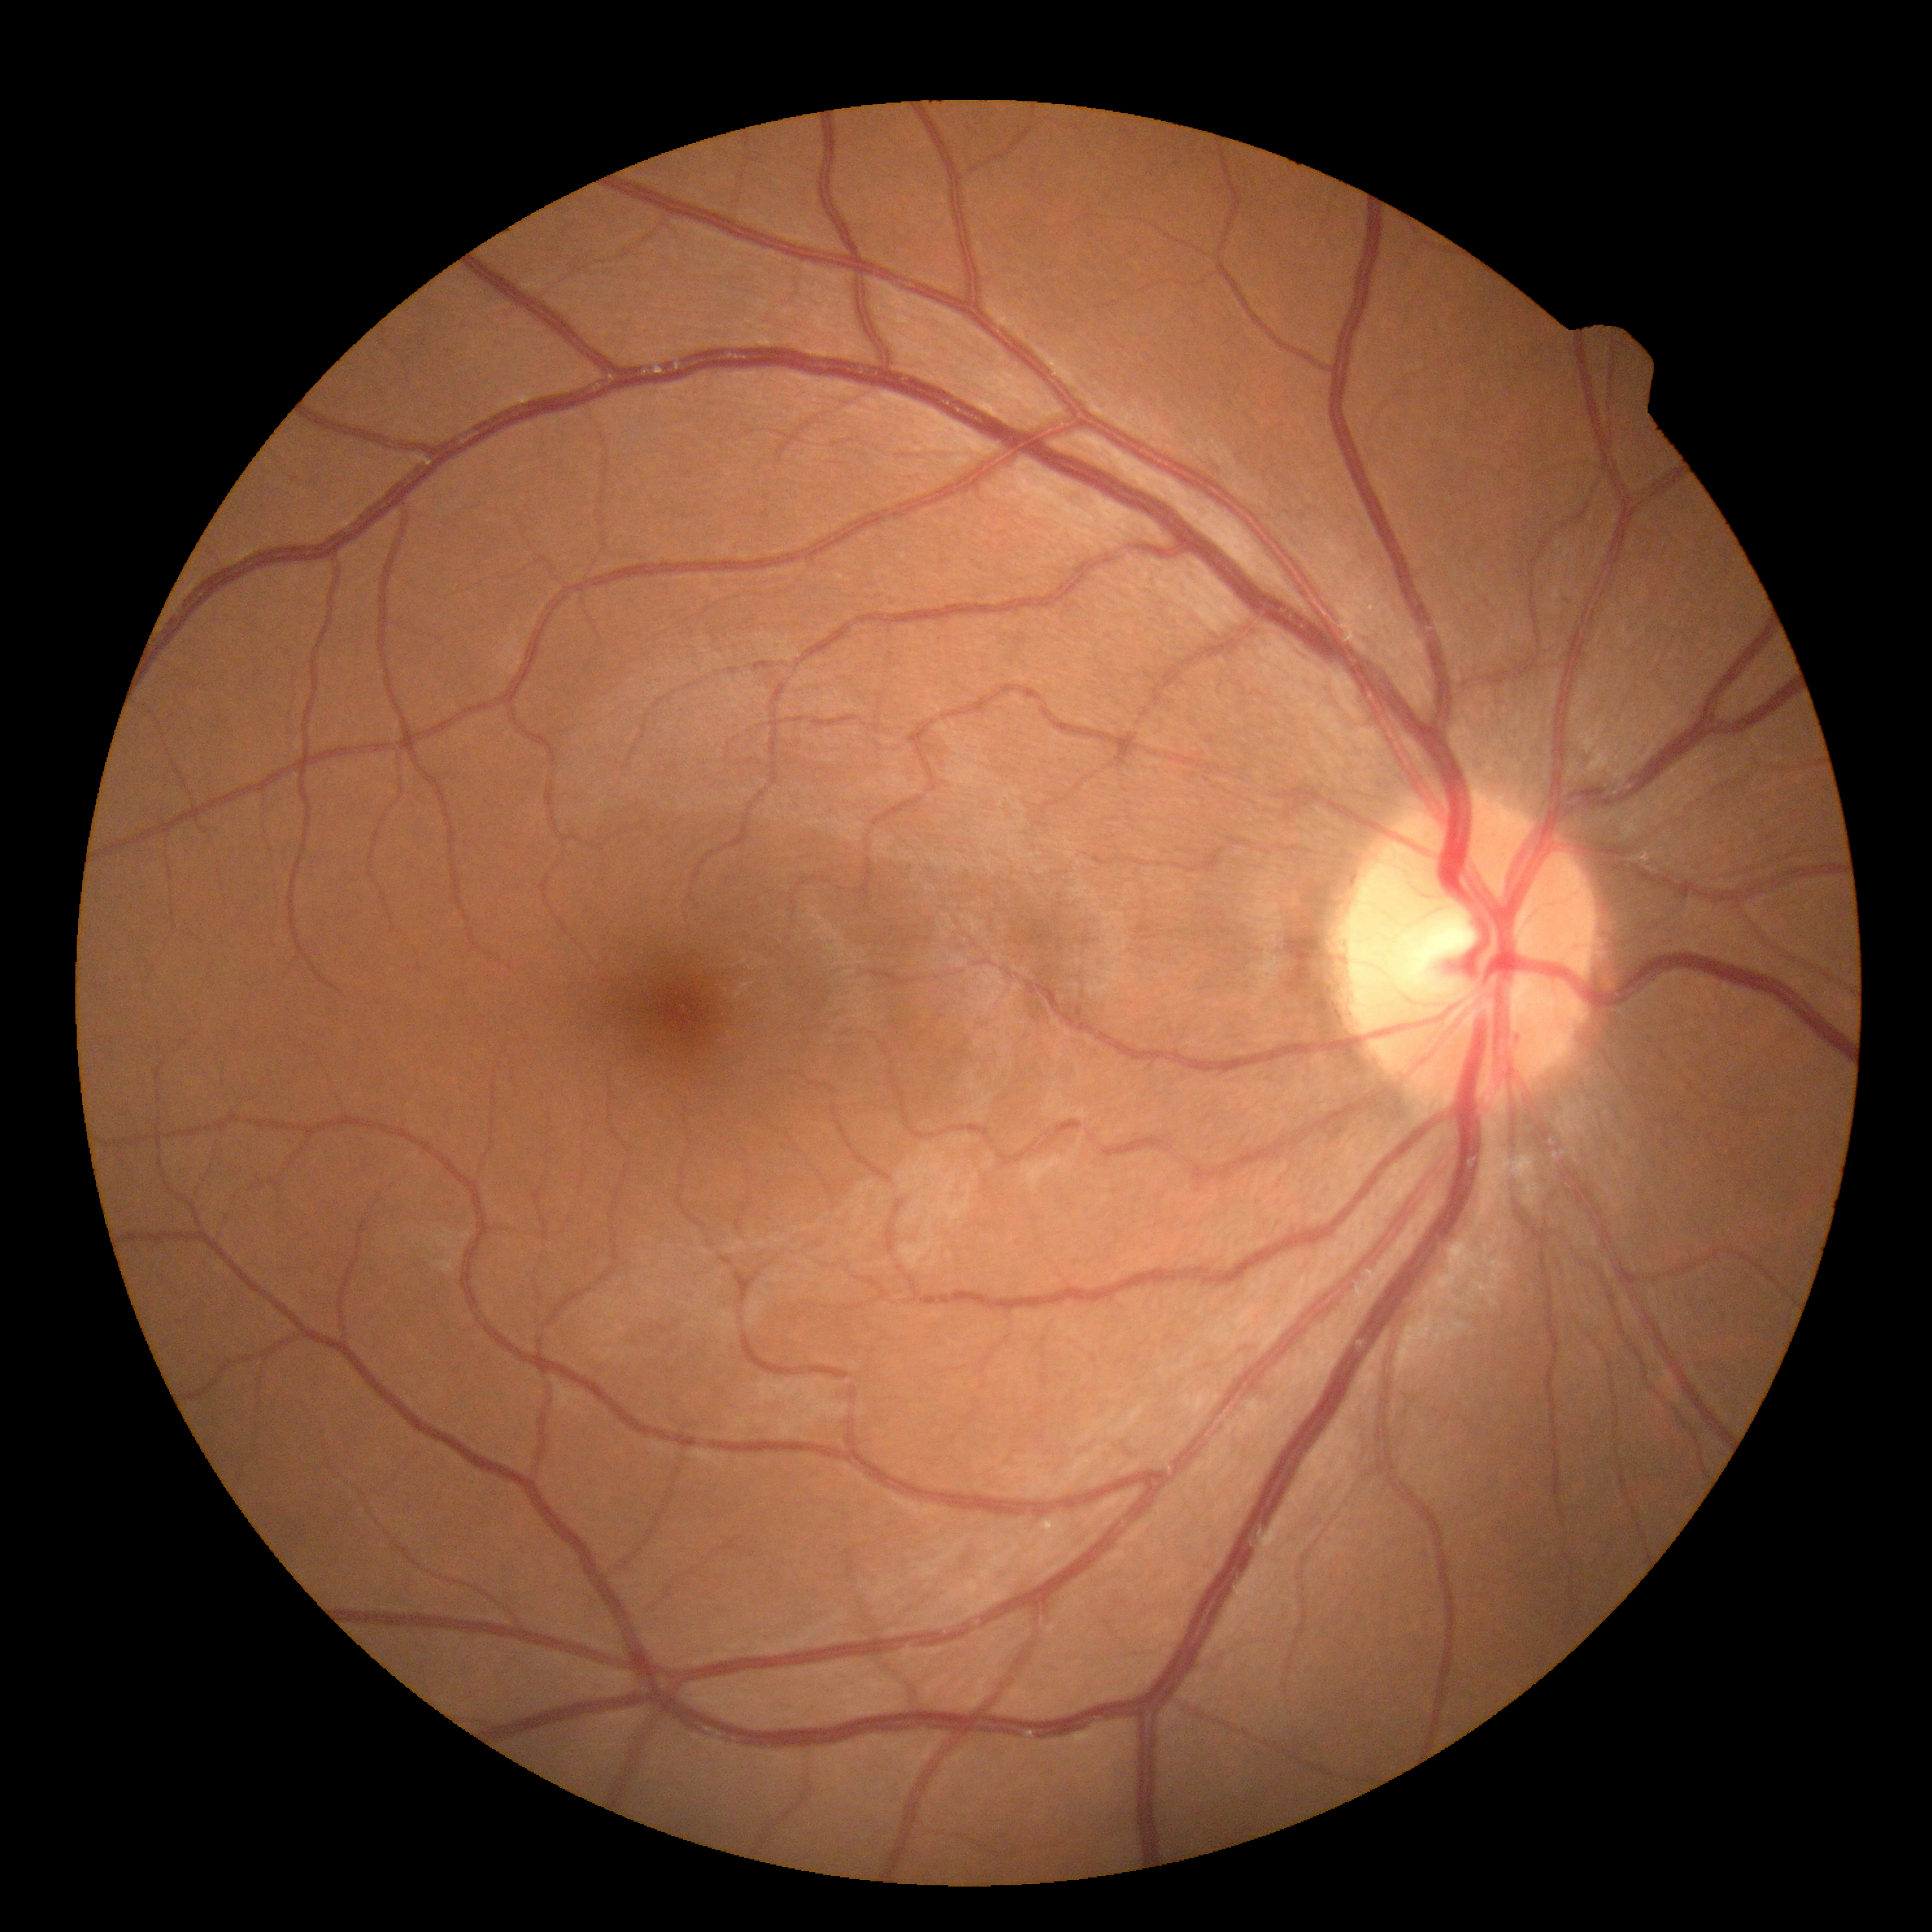
No signs of diabetic retinopathy. DR stage: grade 0.